Pediatric retinal photograph (wide-field) · camera: Natus RetCam Envision (130° FOV) — 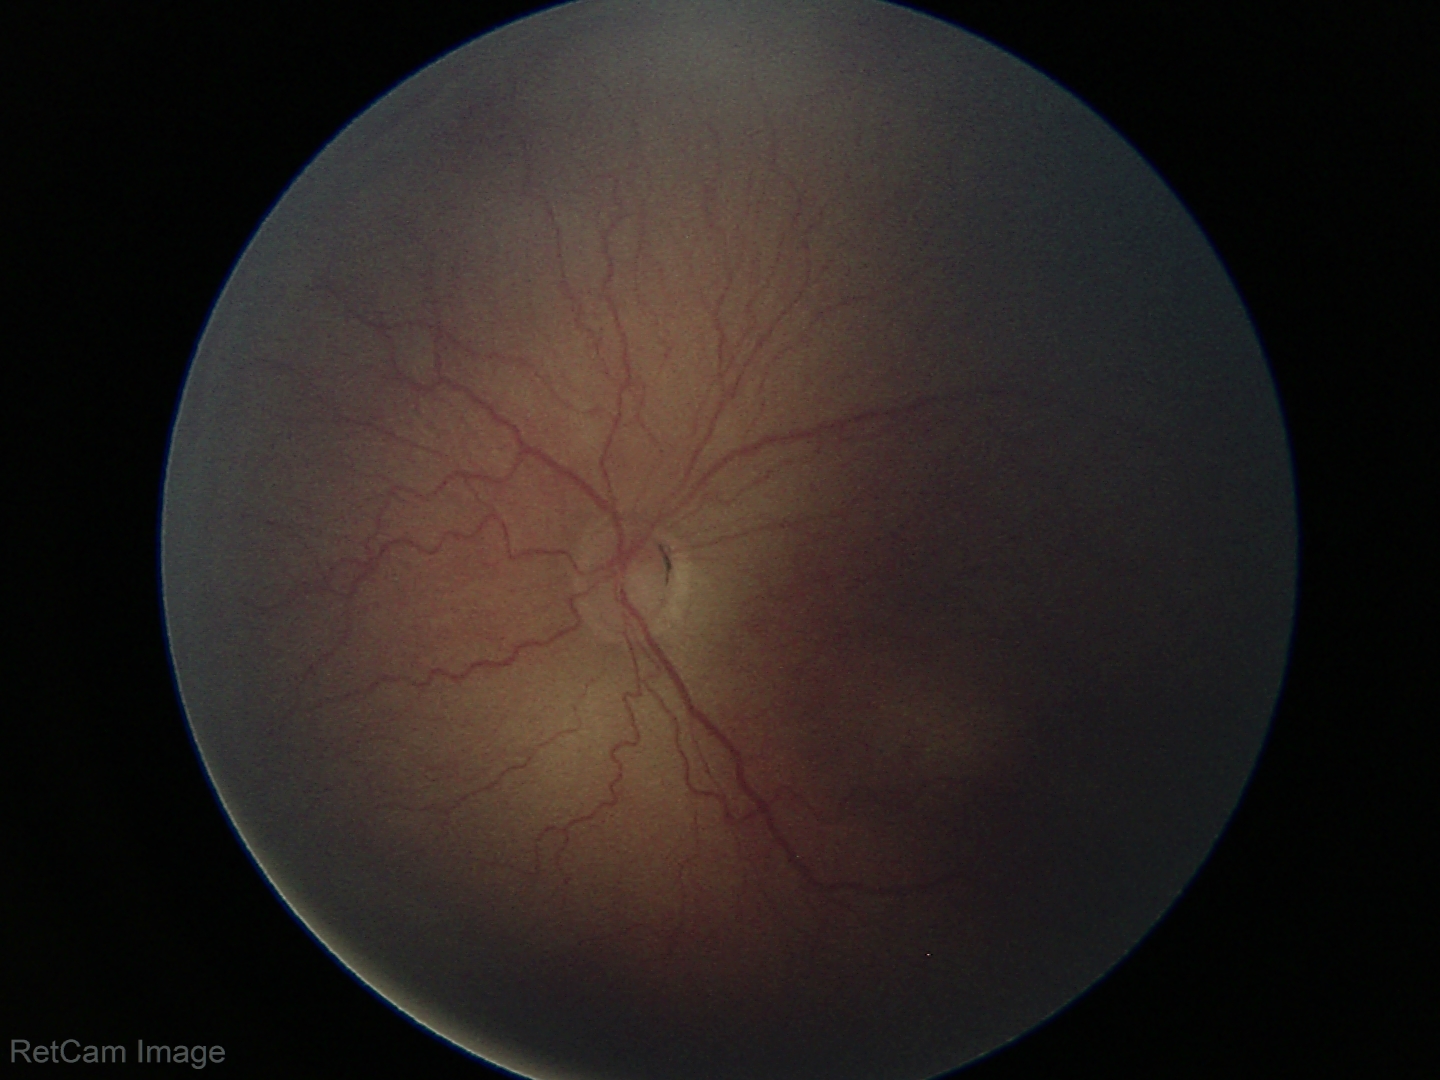

Q: Plus disease status?
A: no plus disease
Q: What was the screening finding?
A: ROP stage 2